DR severity per modified Davis staging: 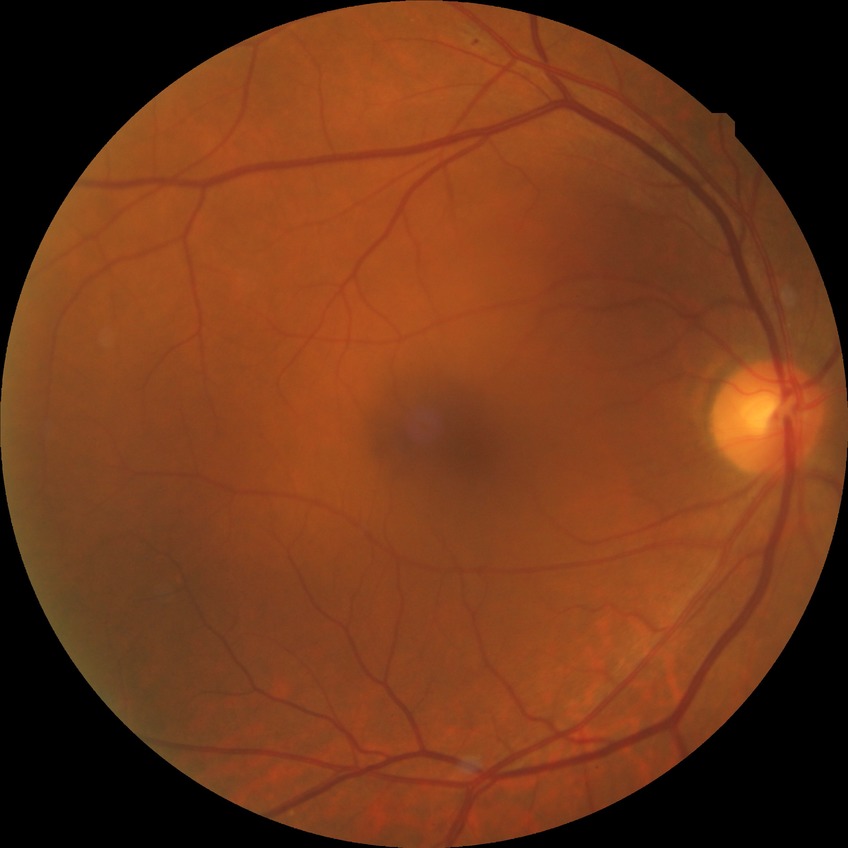
Assessment:
* diabetic retinopathy (DR): SDR (simple diabetic retinopathy)